2352x1568px: 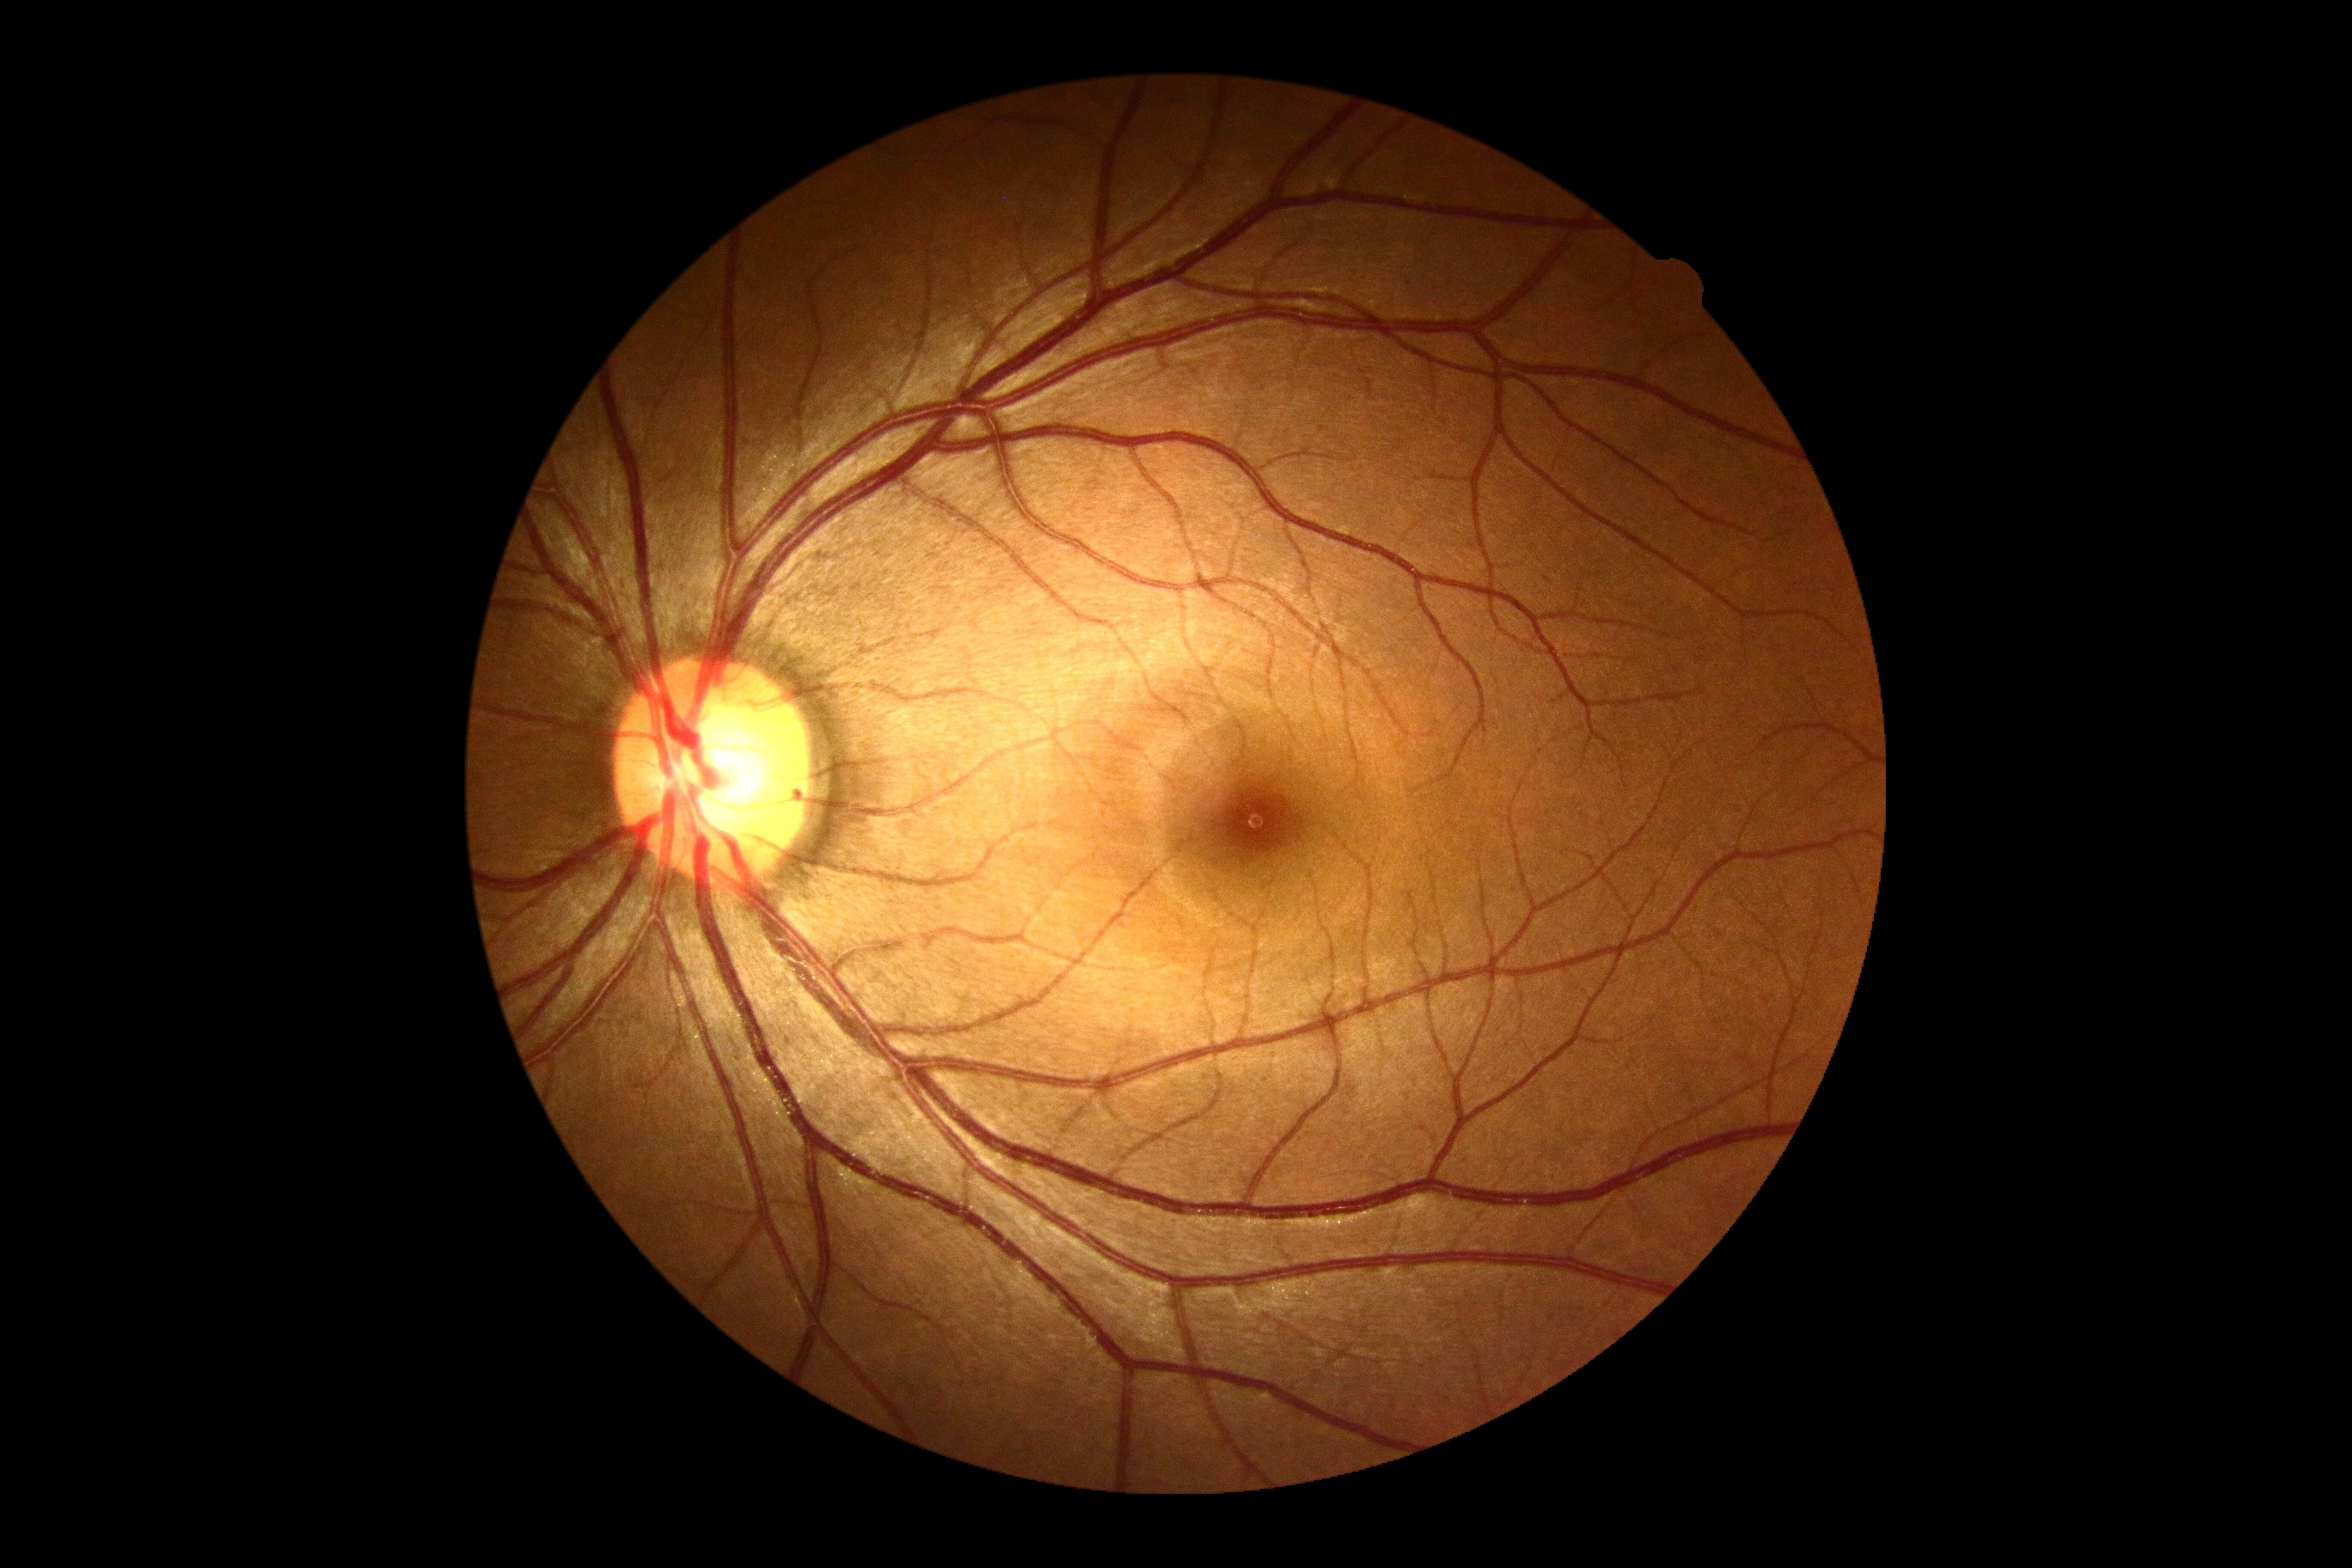 DR grade: 0 (no apparent retinopathy). No apparent diabetic retinopathy.